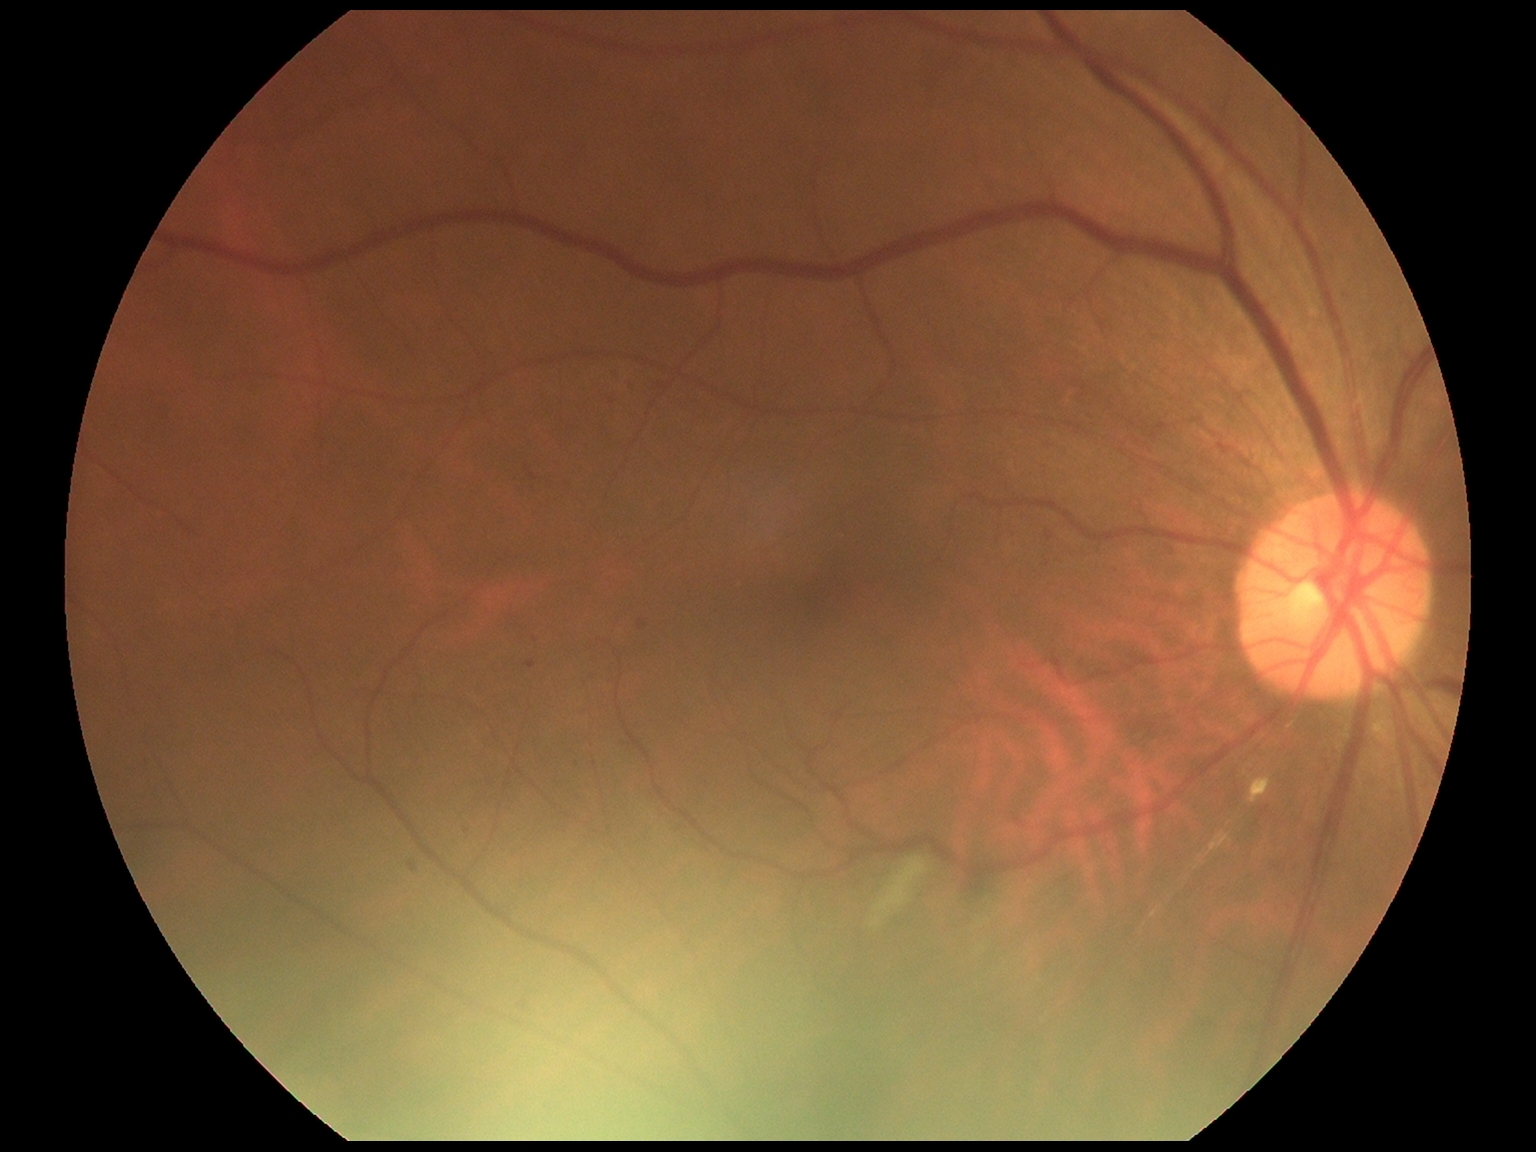 diabetic retinopathy (DR) = moderate non-proliferative diabetic retinopathy (grade 2).